1240 by 1240 pixels. Wide-field contact fundus photograph of an infant
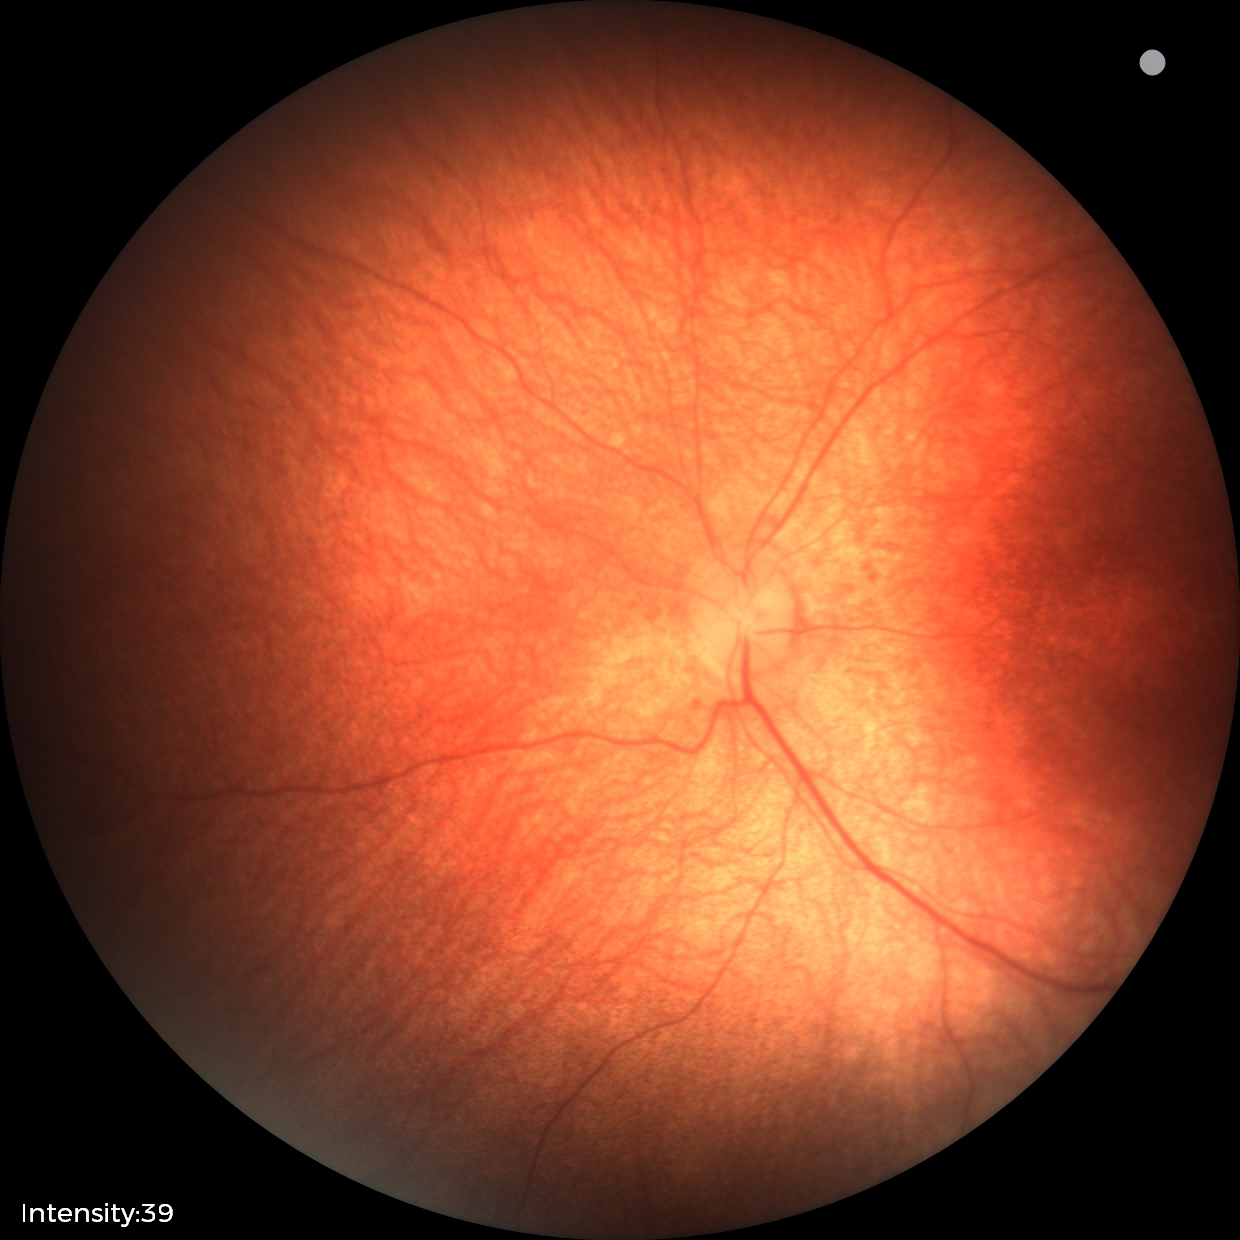

Finding: no abnormalities